45-degree field of view · CFP · modified Davis grading · NIDEK AFC-230
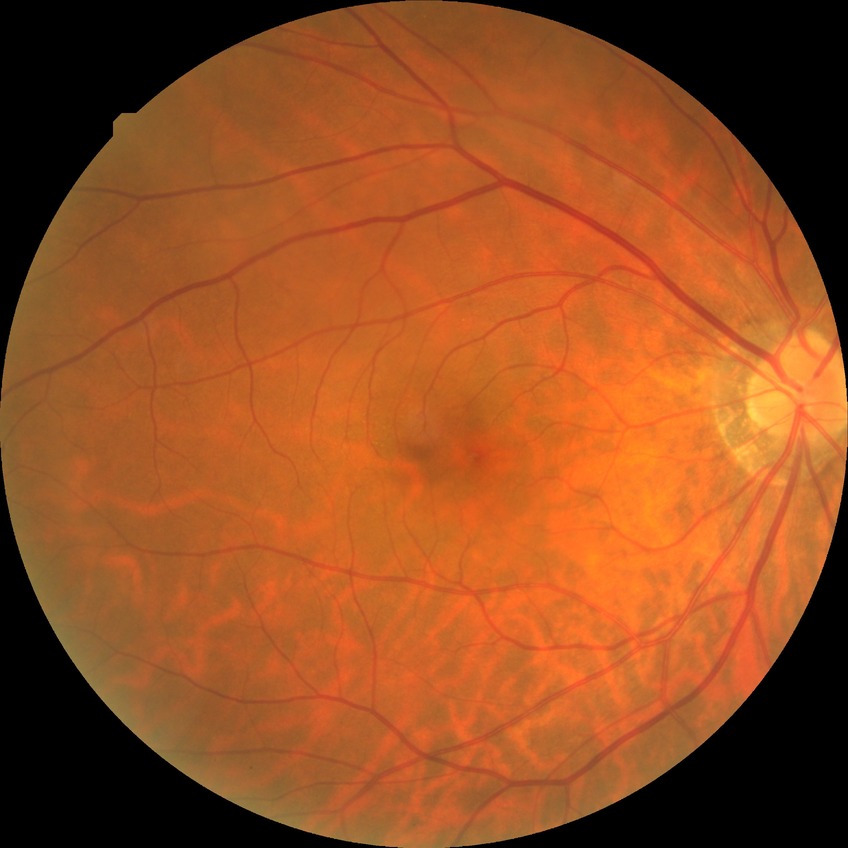 No diabetic retinal disease findings. Modified Davis grade: NDR.